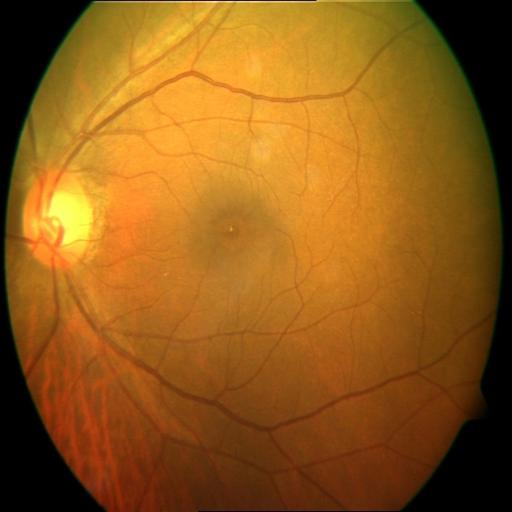 Fundus appearance consistent with optic disc cupping.